FOV: 45 degrees: 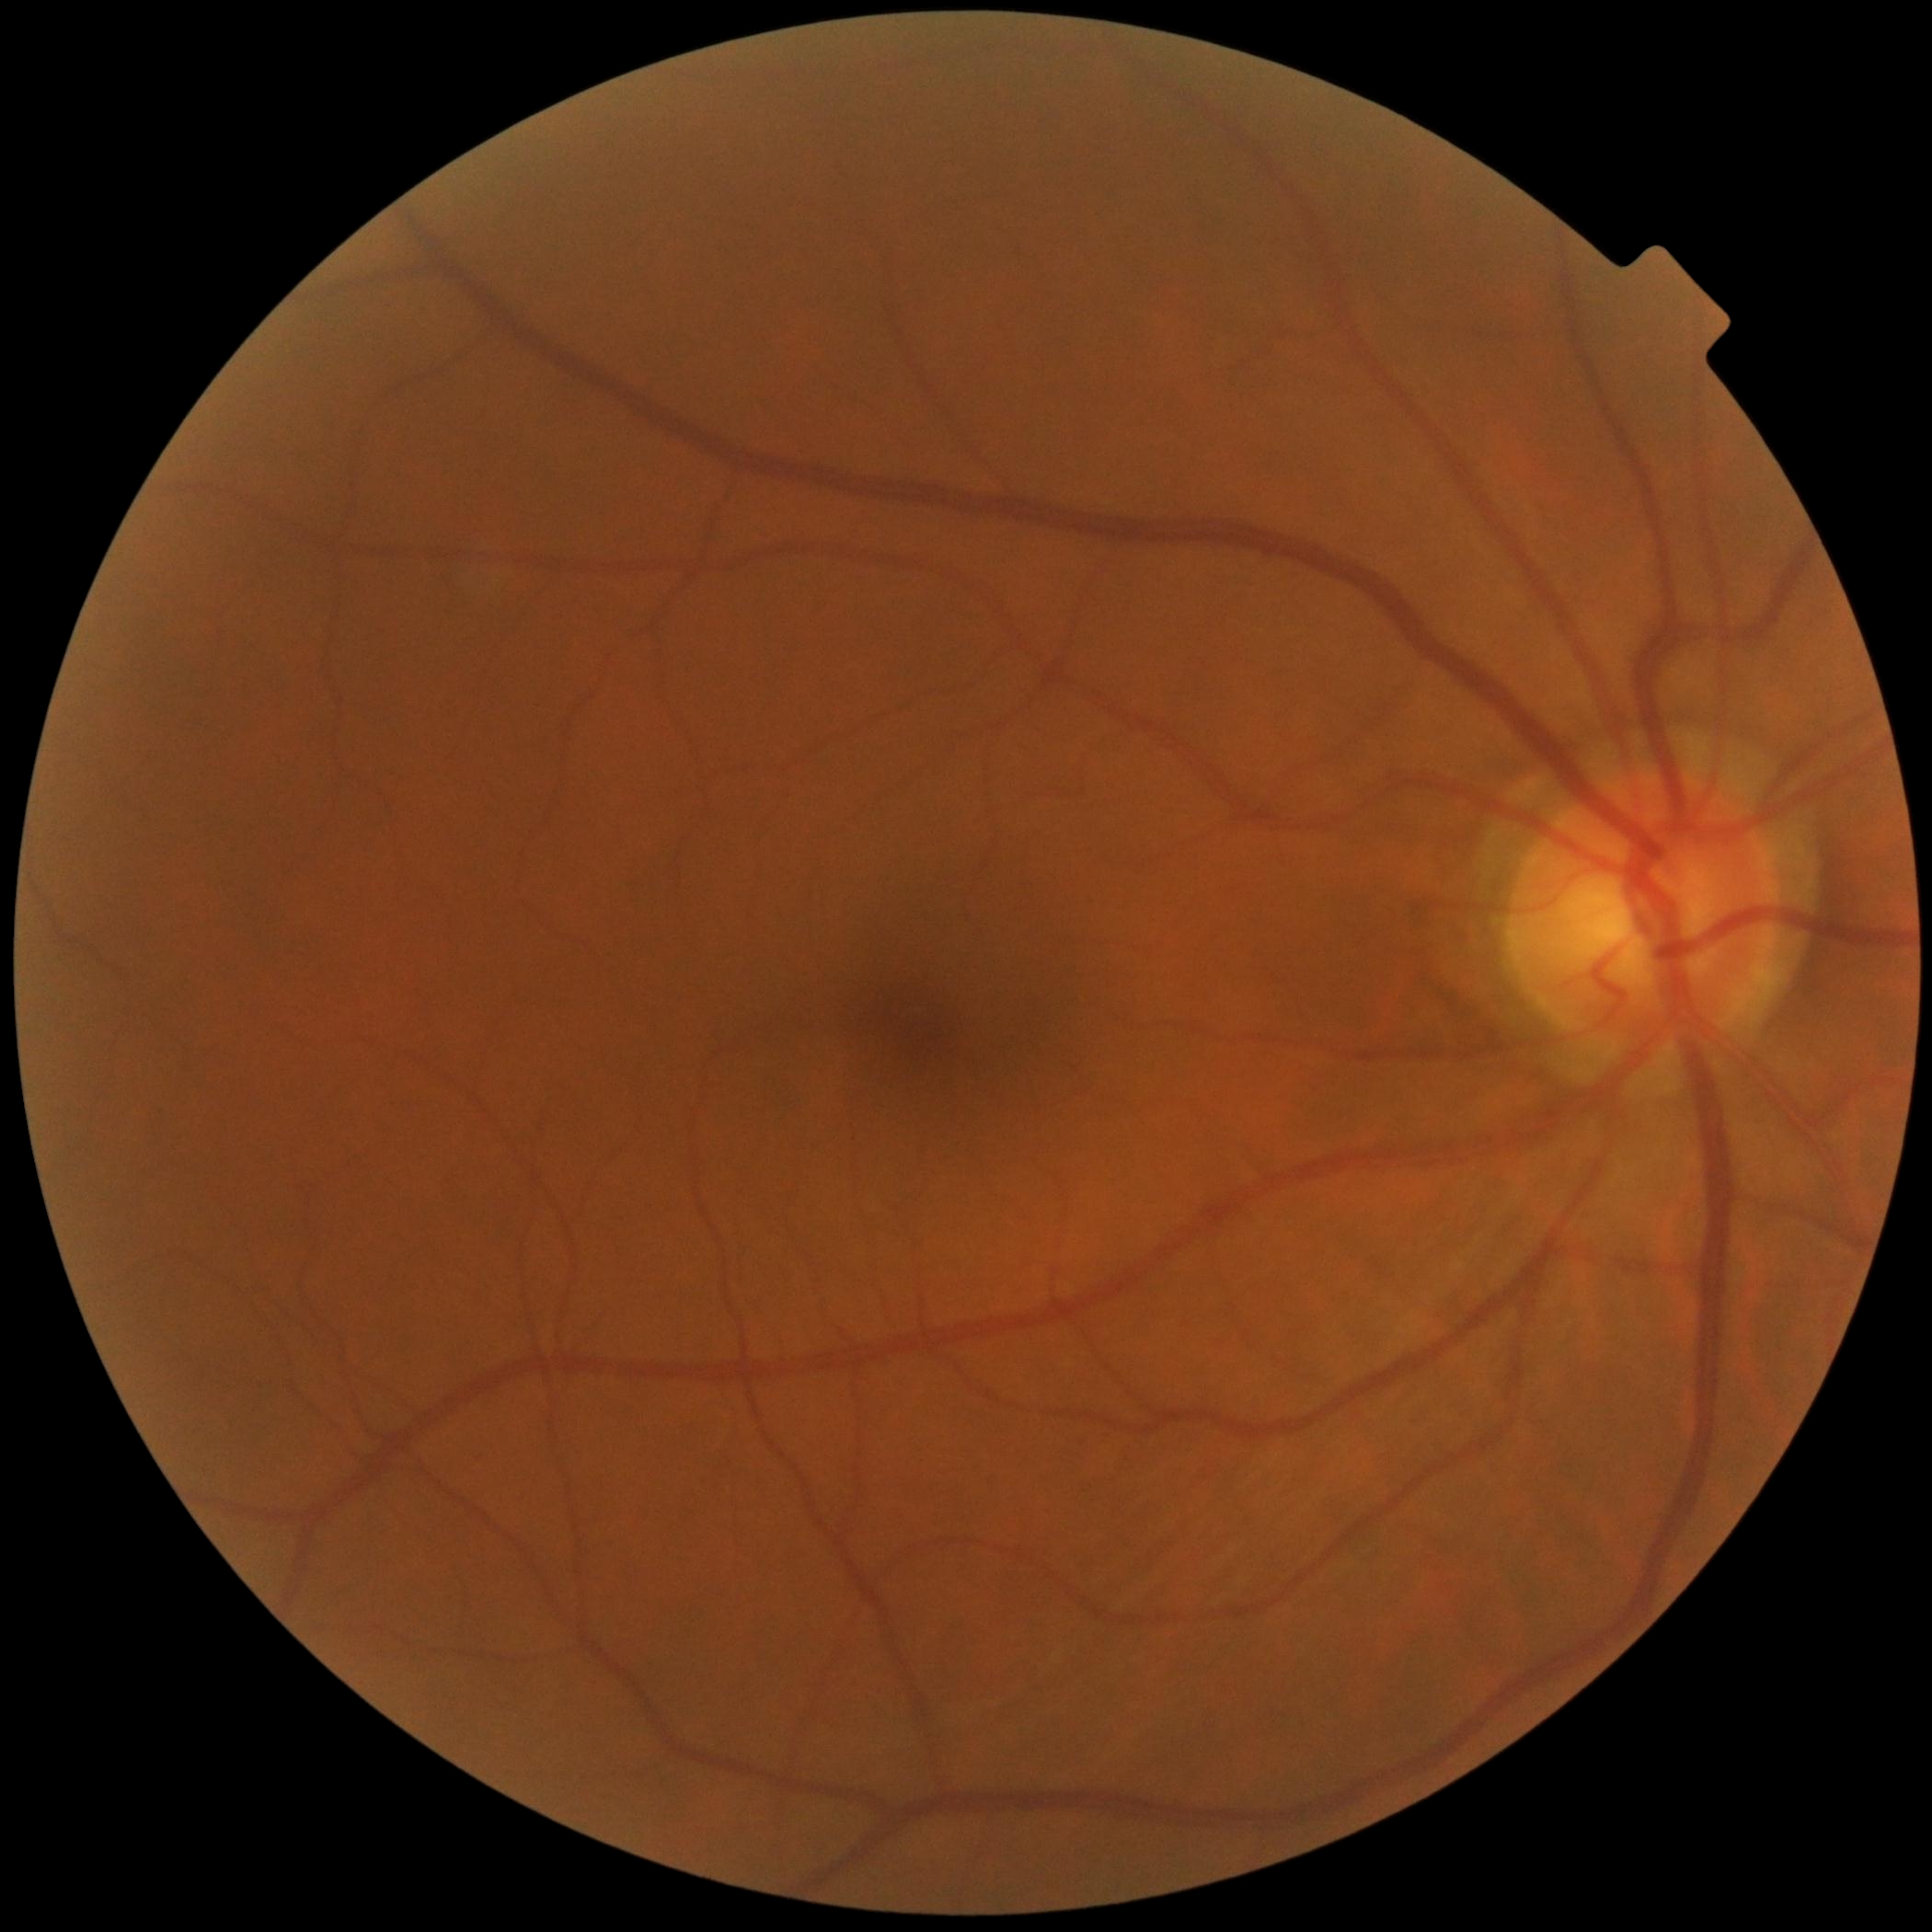 – DR impression: no signs of DR
– diabetic retinopathy grade: 0 (no apparent retinopathy)